Retinal fundus photograph:
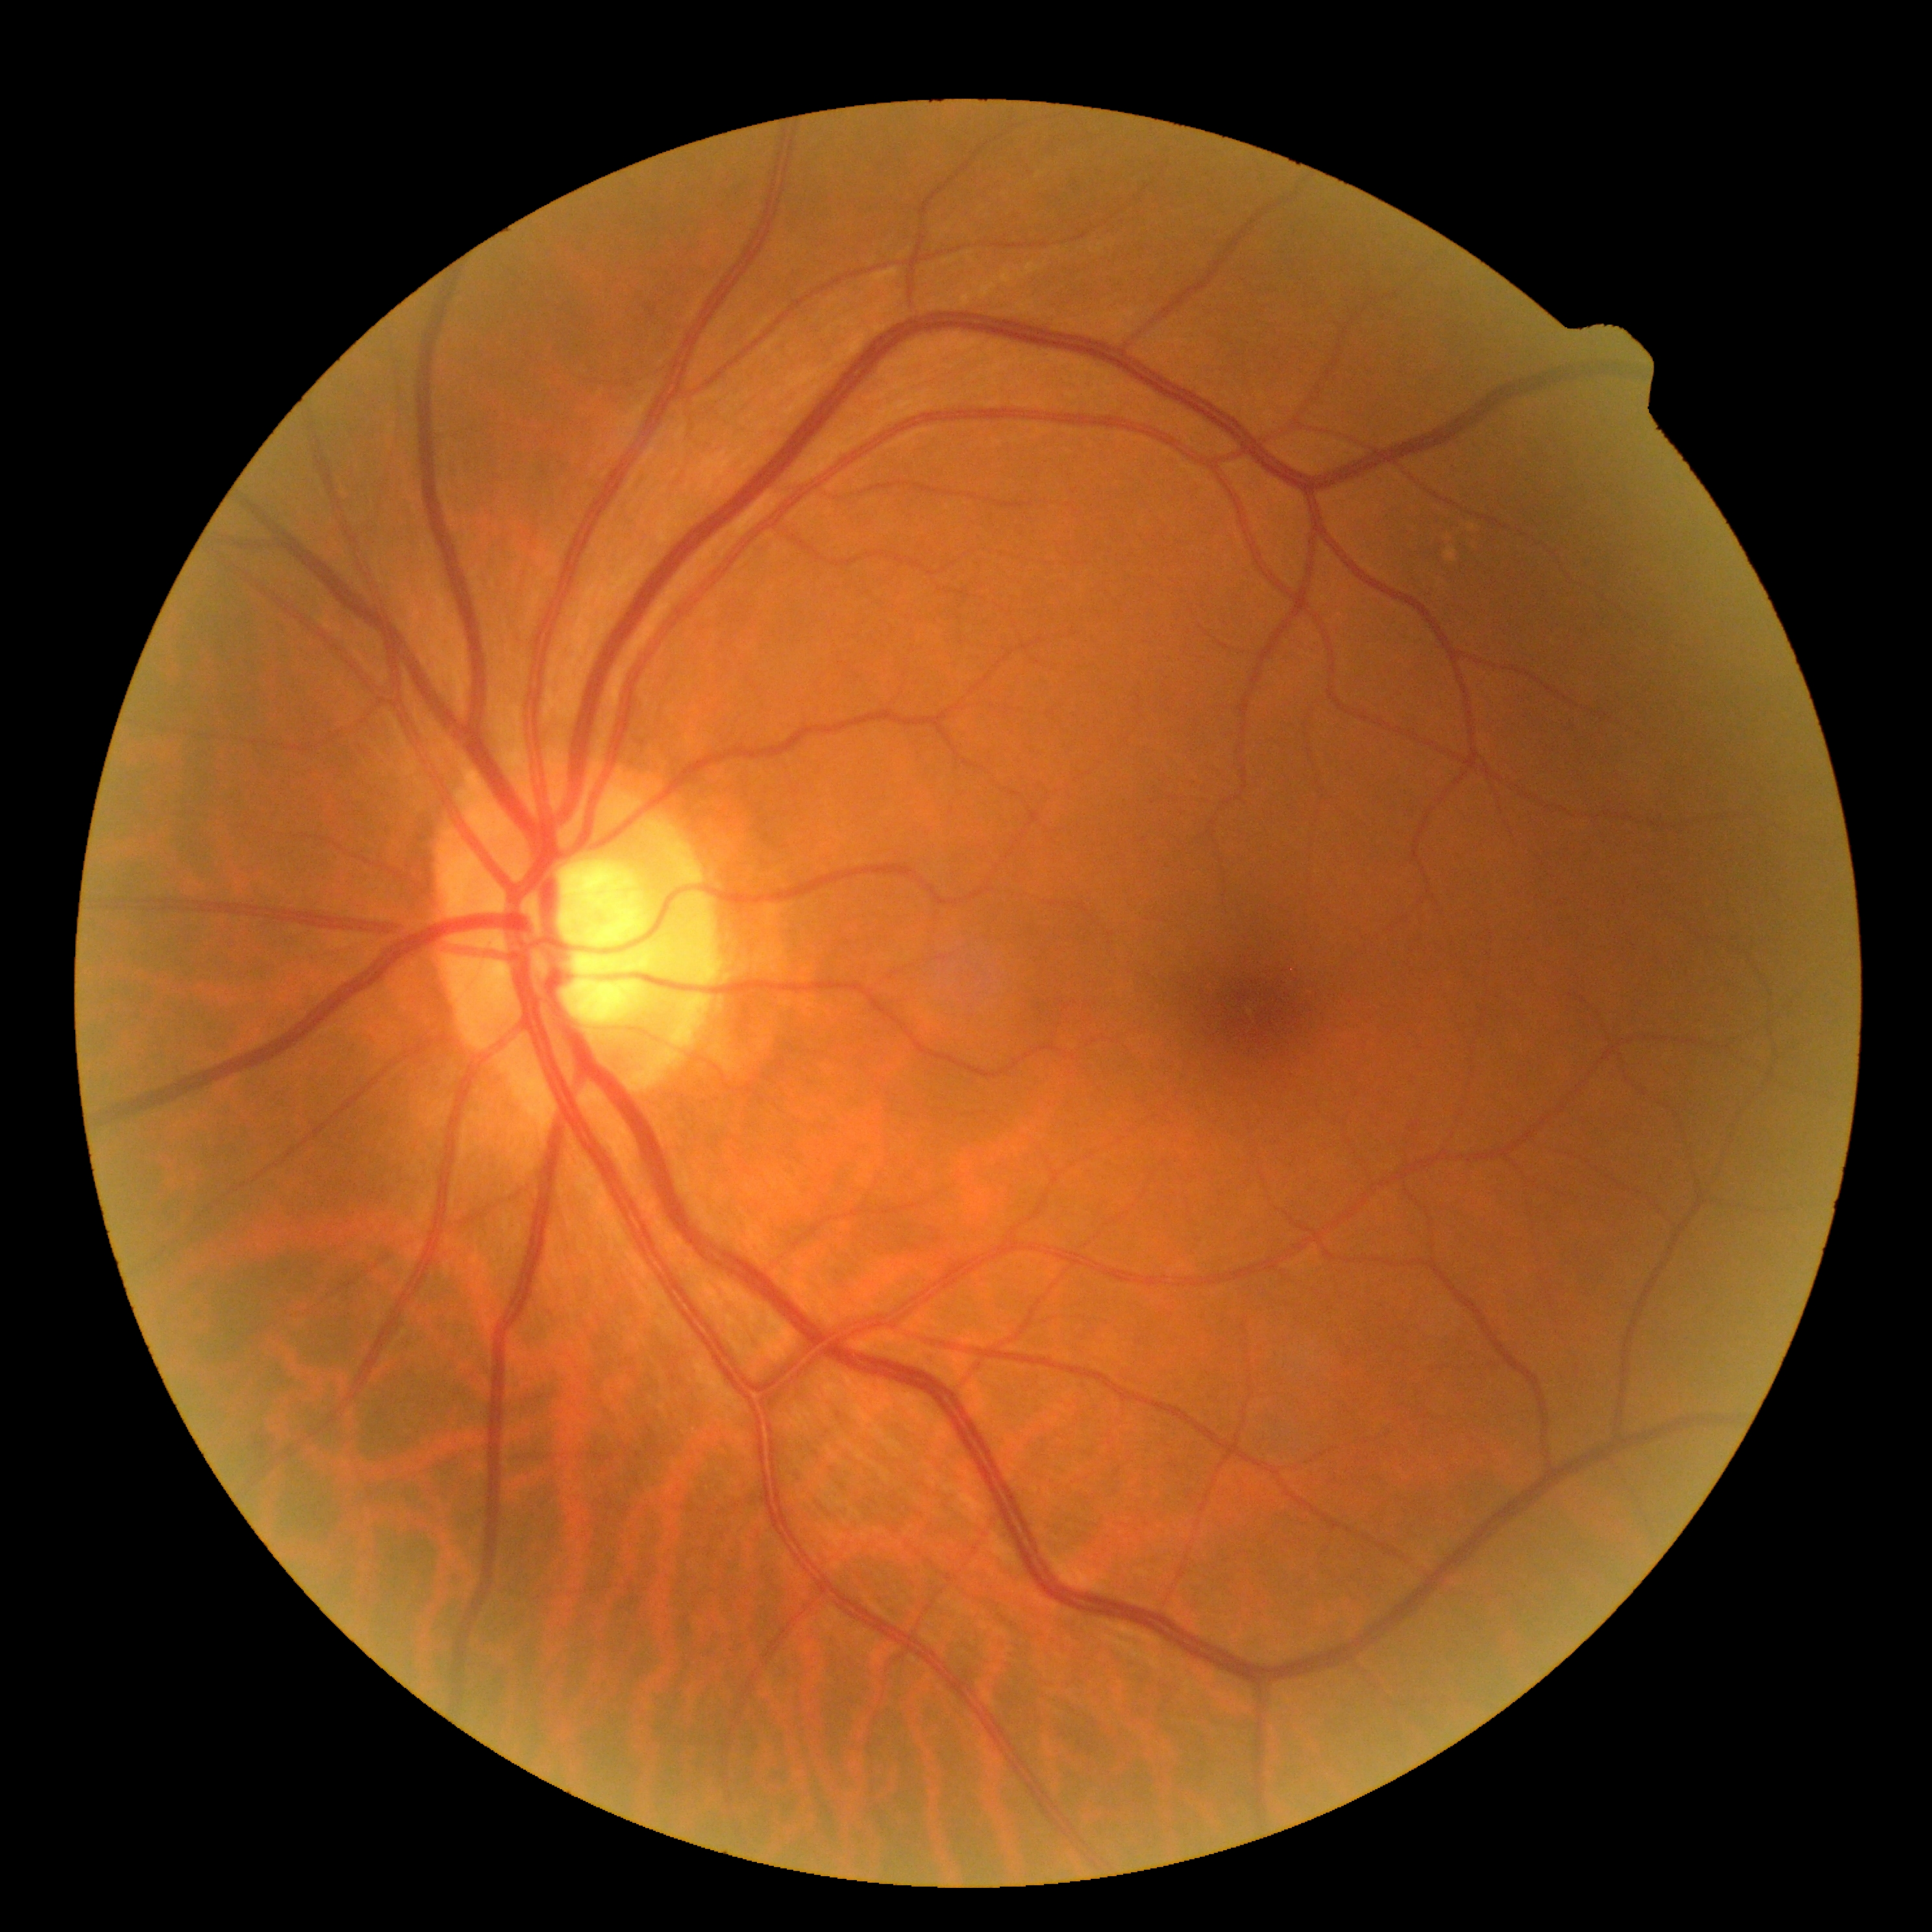
diabetic retinopathy (DR) = grade 0 (no apparent retinopathy) — no visible signs of diabetic retinopathy.